512x512 · fundus photo
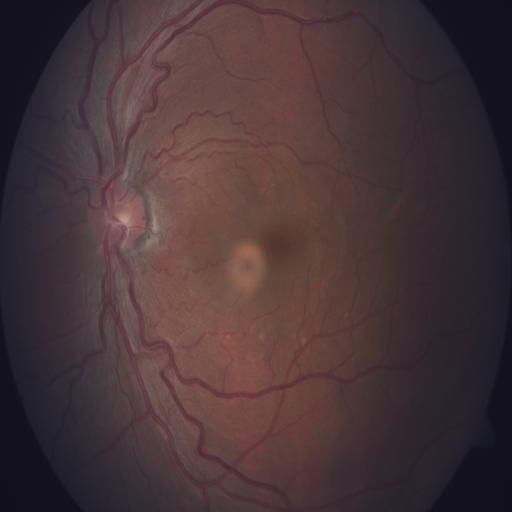 The image shows tortuous vessels.